Clarity RetCam 3, 130° FOV · RetCam wide-field infant fundus image
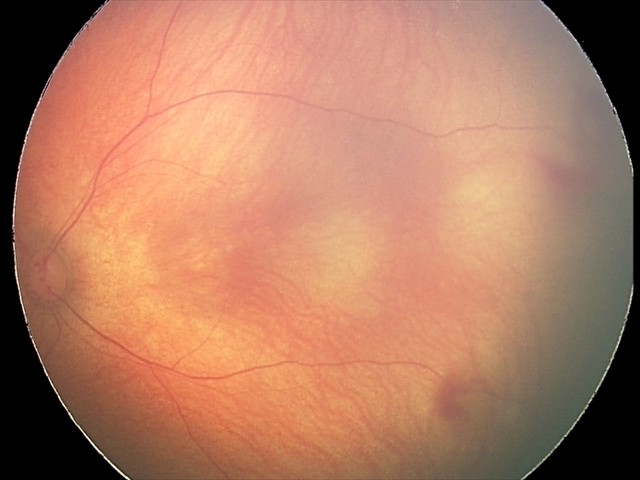
Examination diagnosed as retinal hemorrhages.